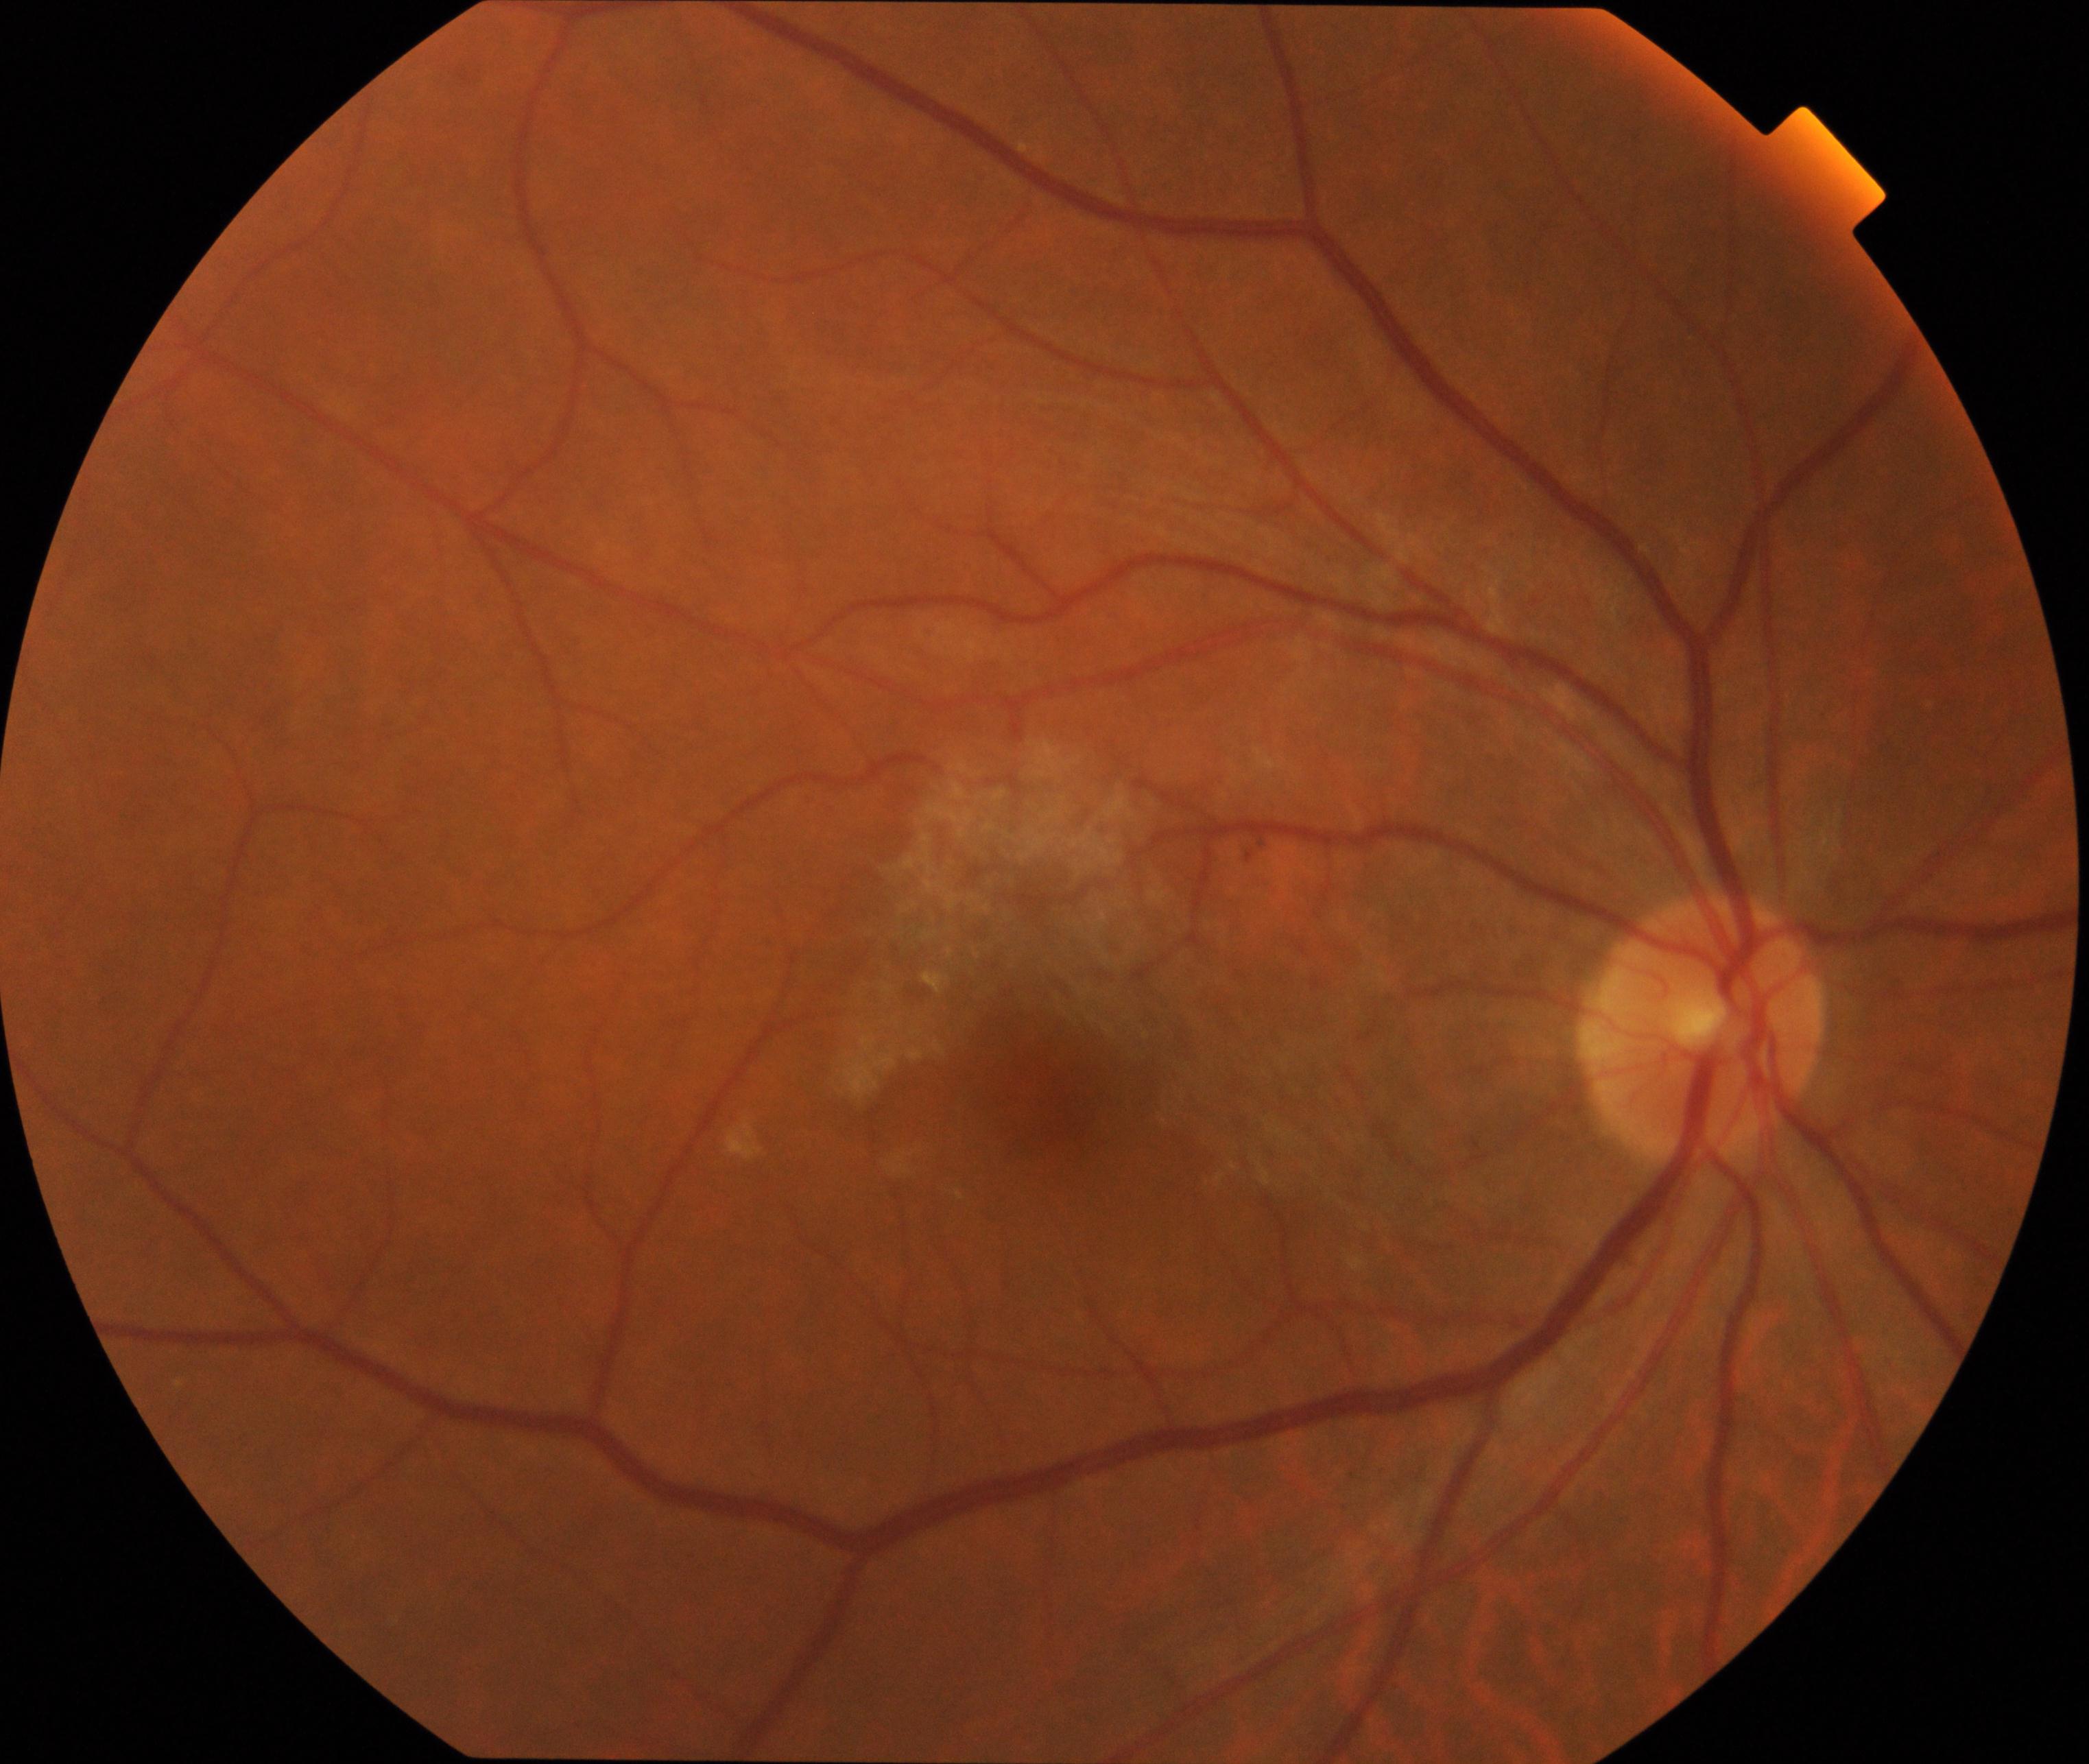
Appearance consistent with epiretinal membrane. Defined by a cellophane-sheen sheet on or above the surface of the retina with macular pucker and distortion of blood vessels within the vessel arcades.